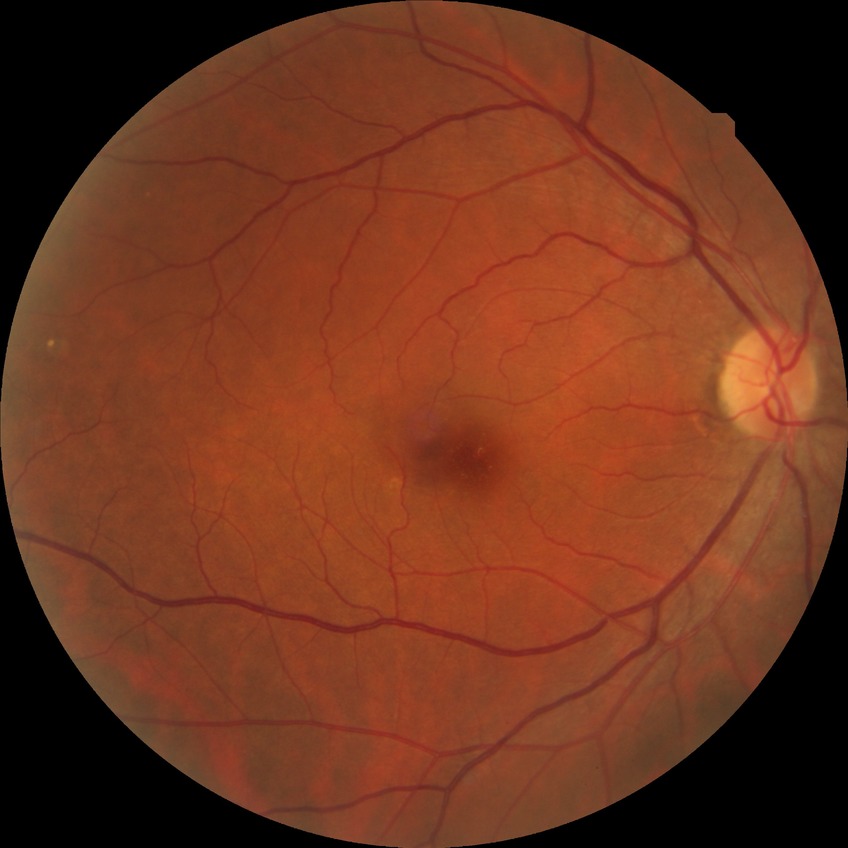 Assessment:
• diabetic retinopathy (DR) — NDR (no diabetic retinopathy)